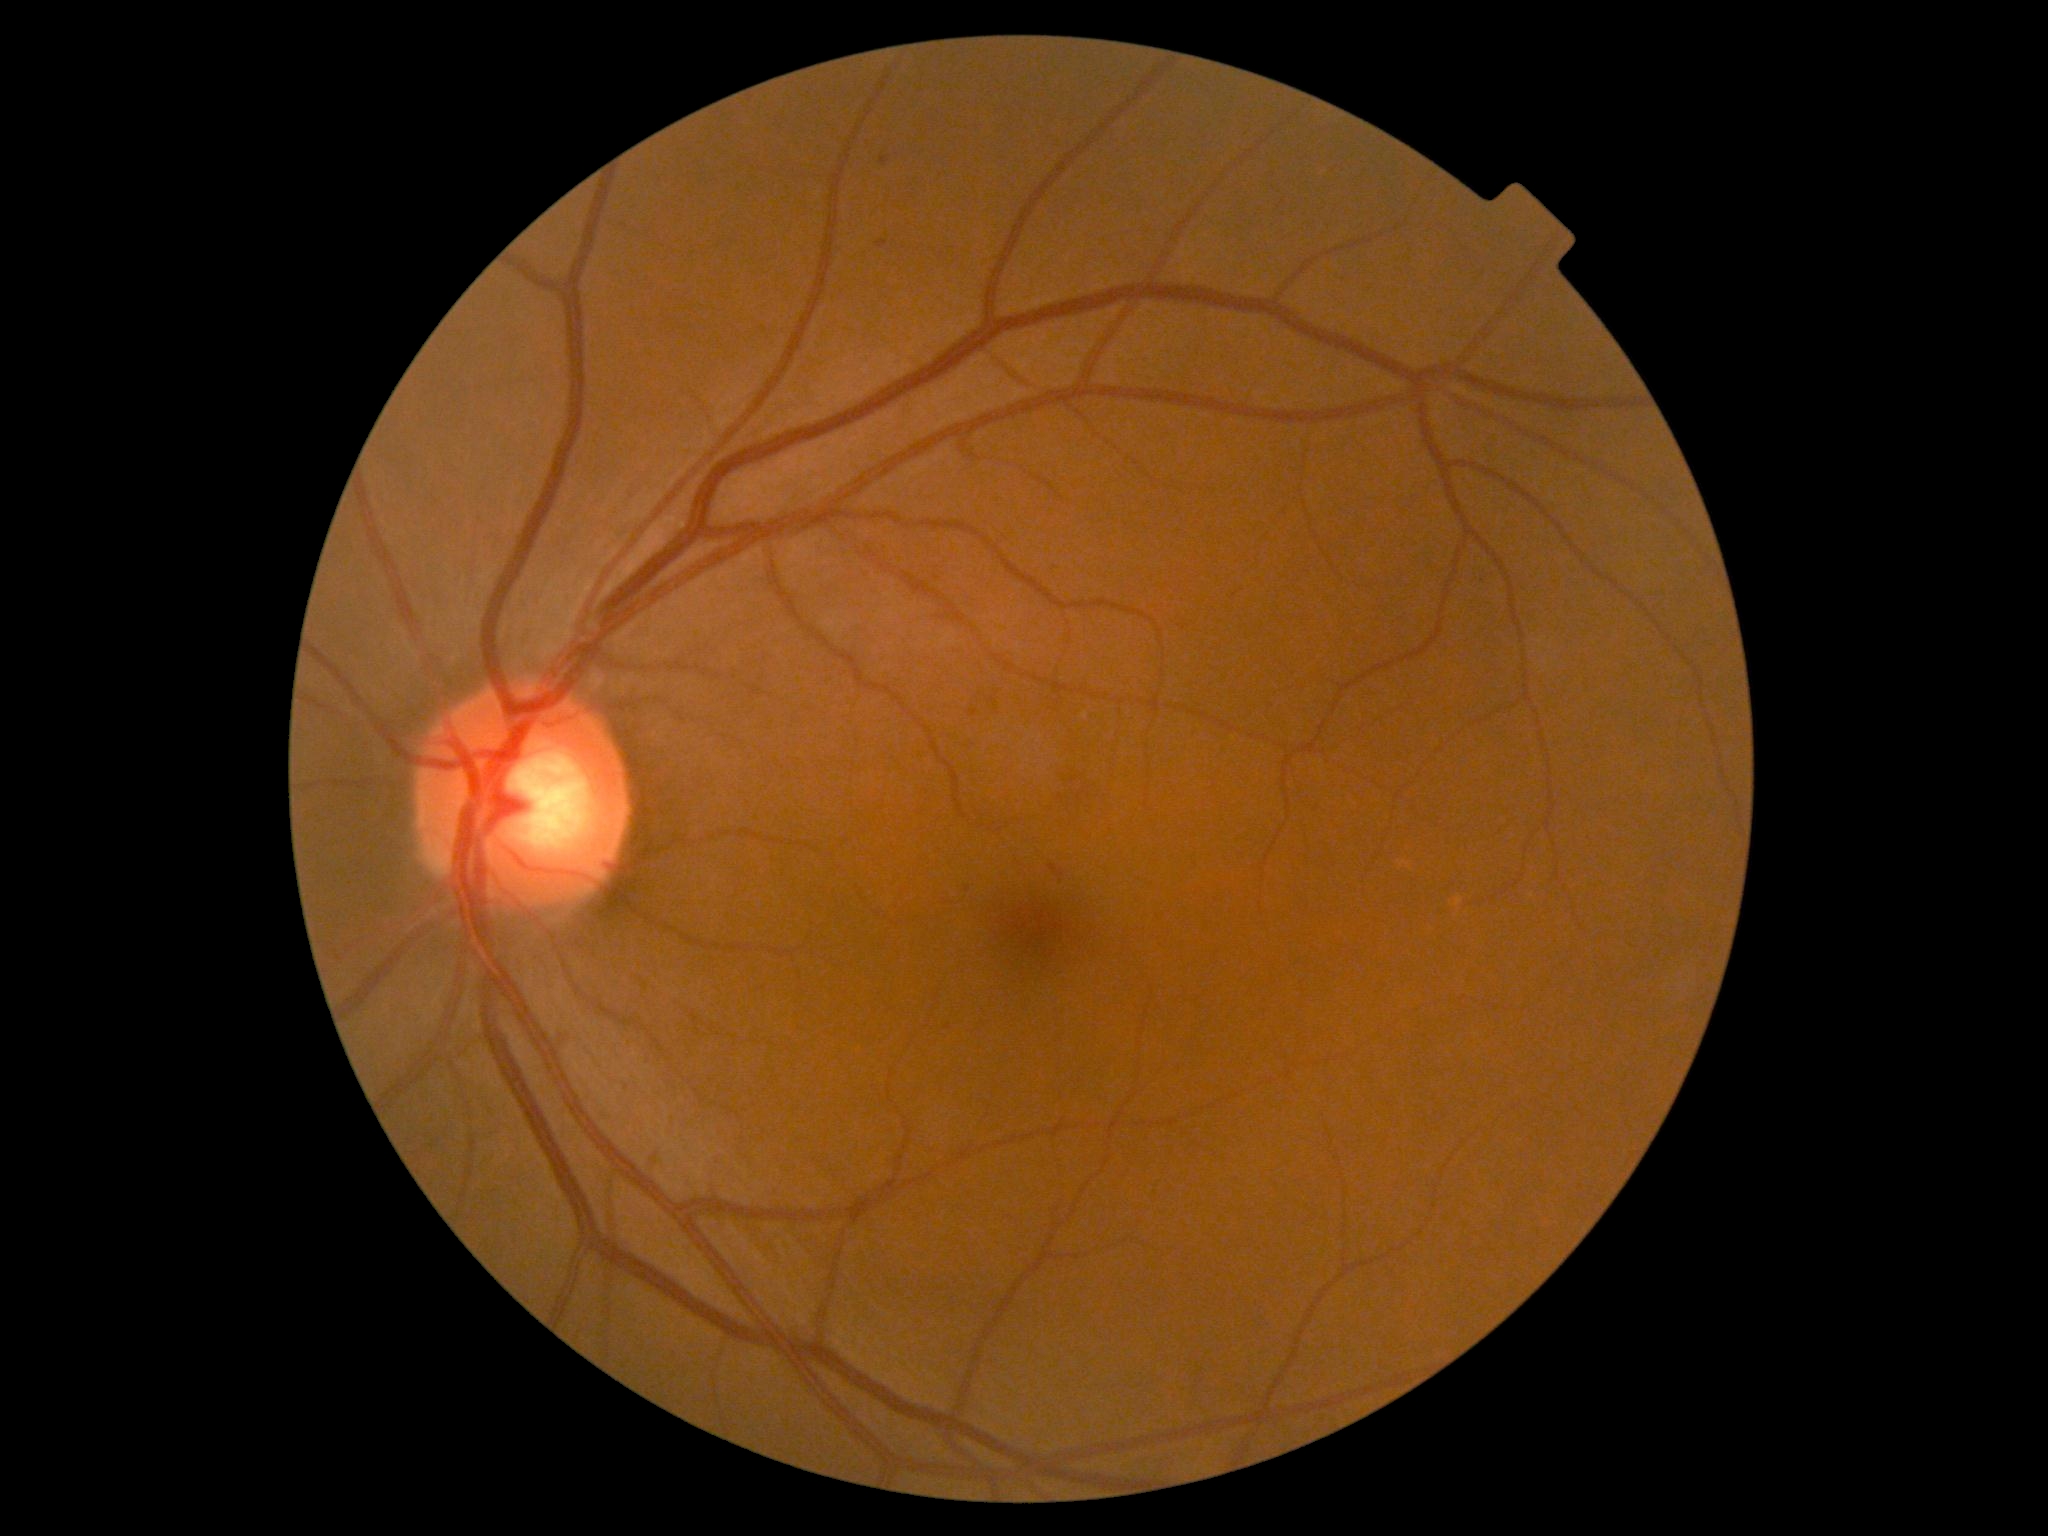

{
  "dr_grade": "1 (mild NPDR)"
}